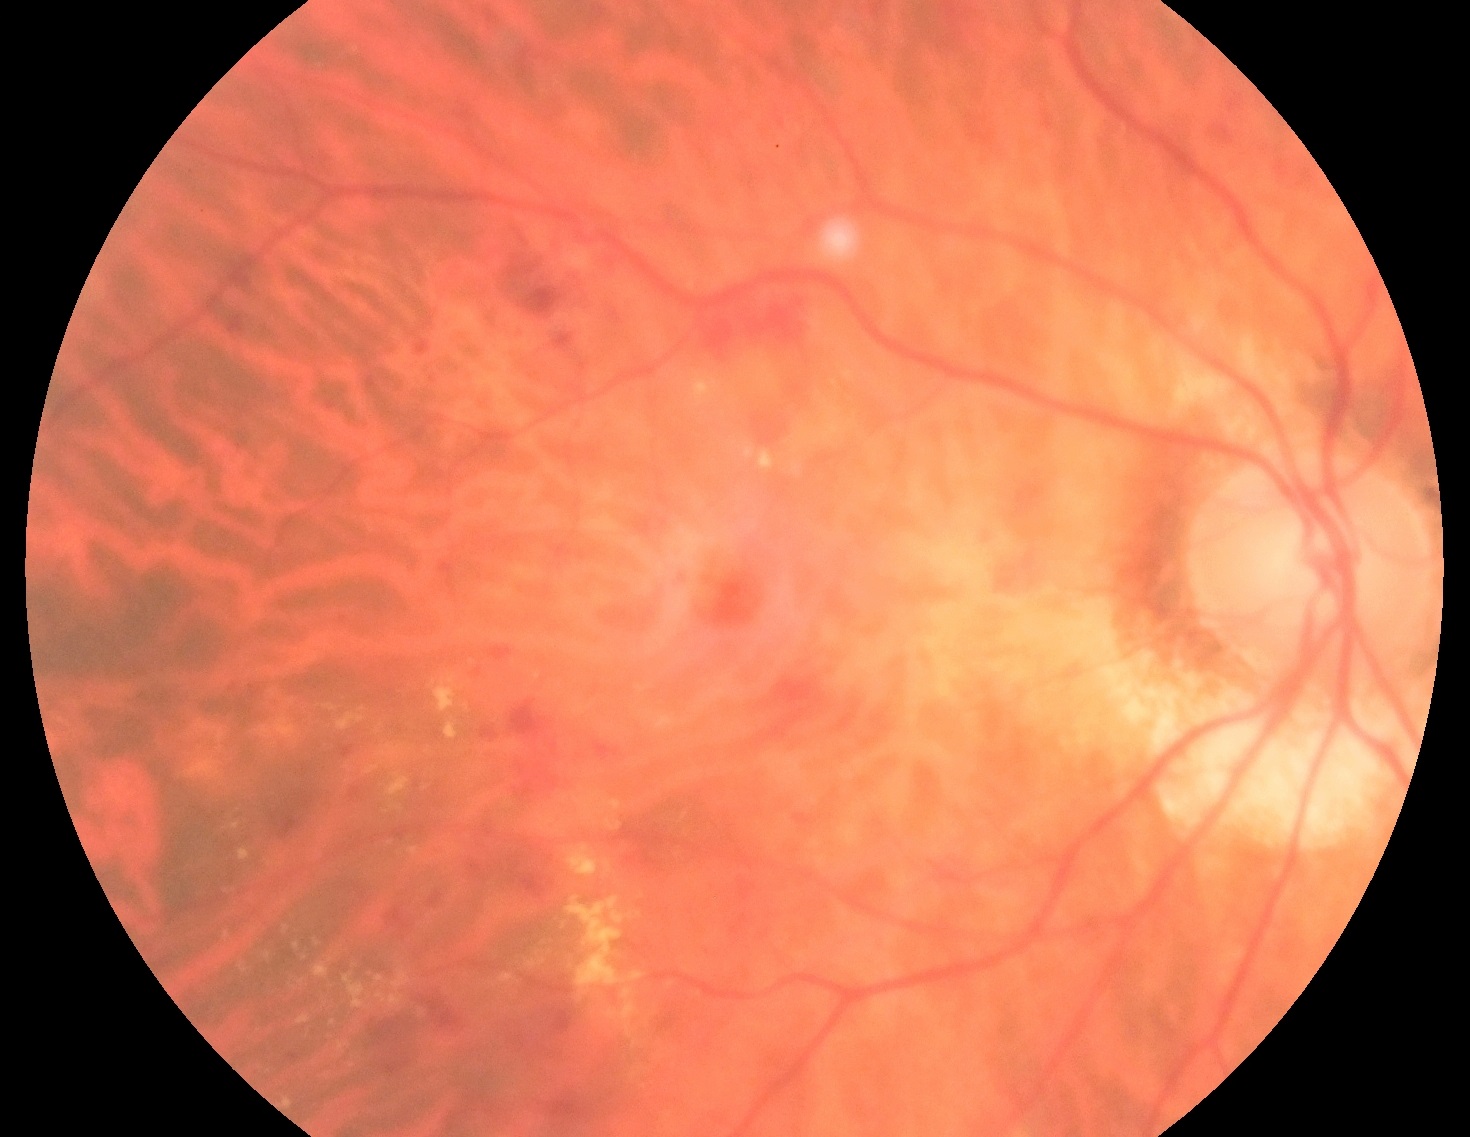
– DR — grade 2